Wide-field fundus photograph from neonatal ROP screening
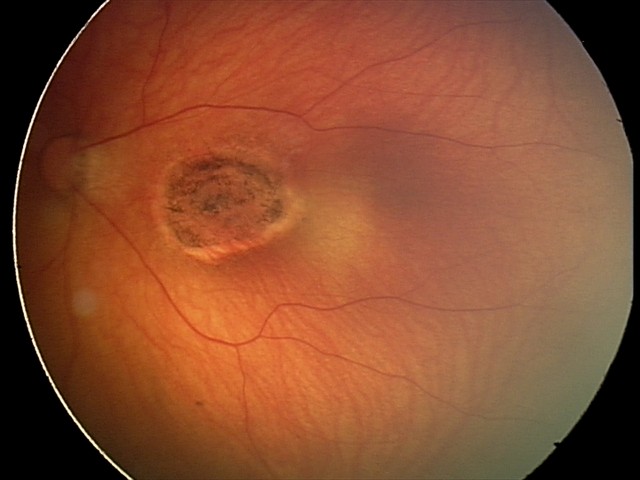

Diagnosis from this screening exam: toxoplasmosis chorioretinitis.